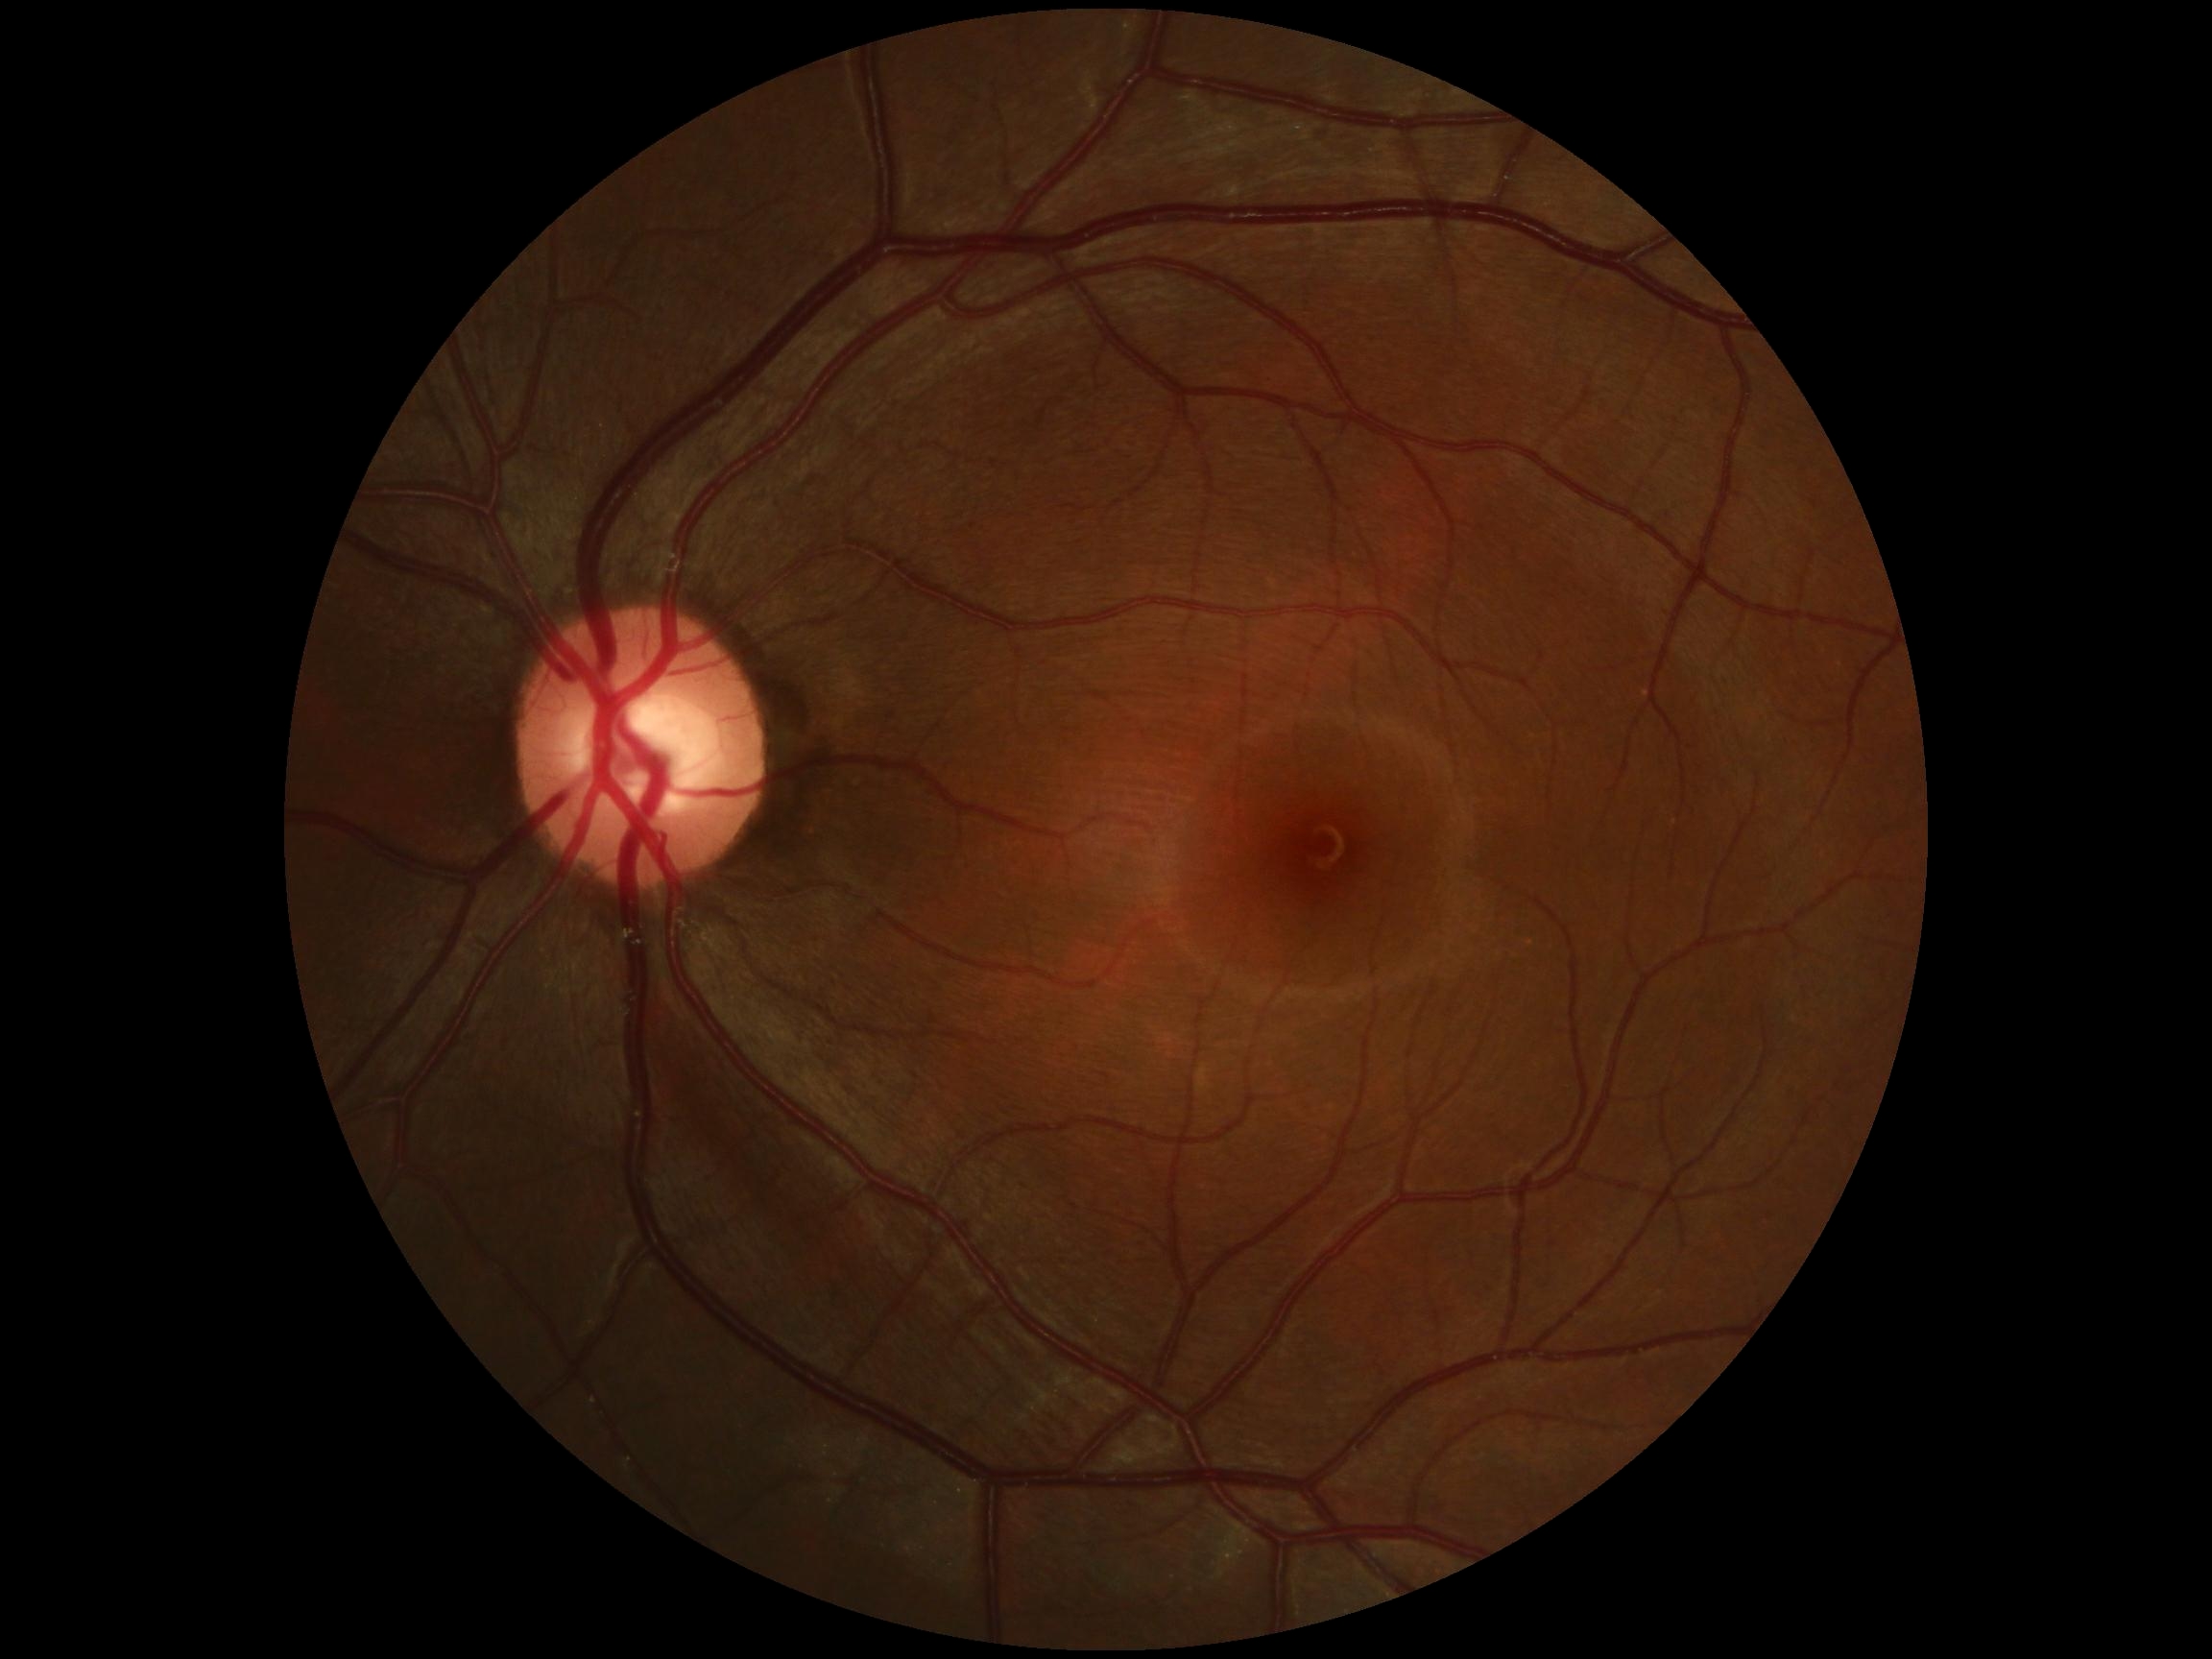 DR grade: 0.